Acquired with a NIDEK AFC-230 · 45-degree field of view · no pharmacologic dilation · color fundus photograph: 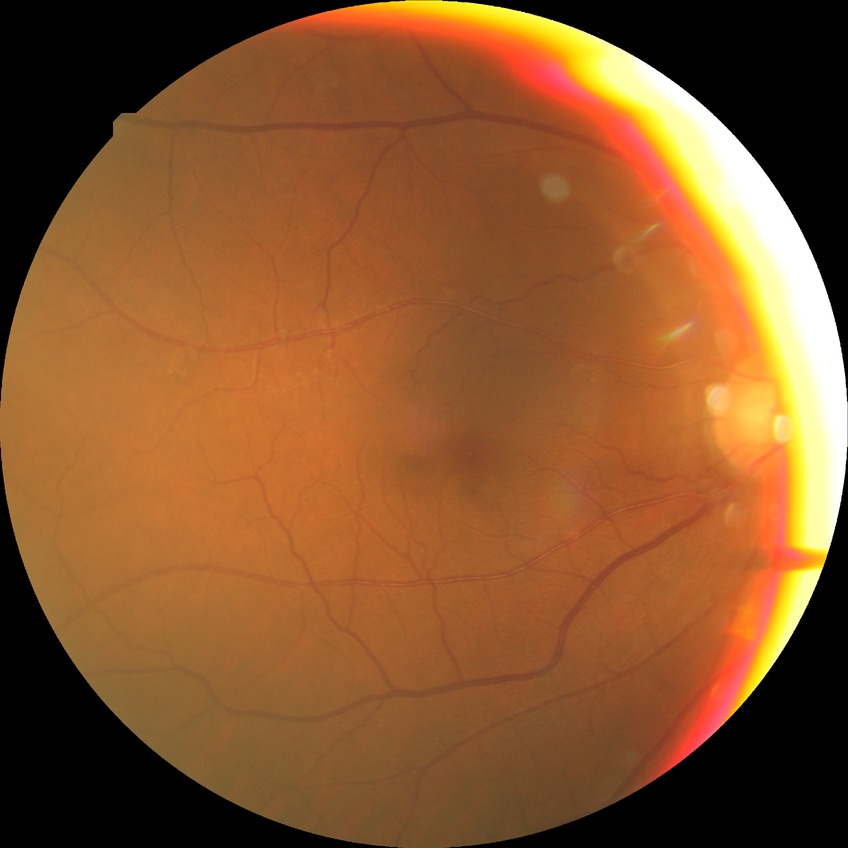

Diabetic retinopathy (DR): NDR (no diabetic retinopathy).